CFP: 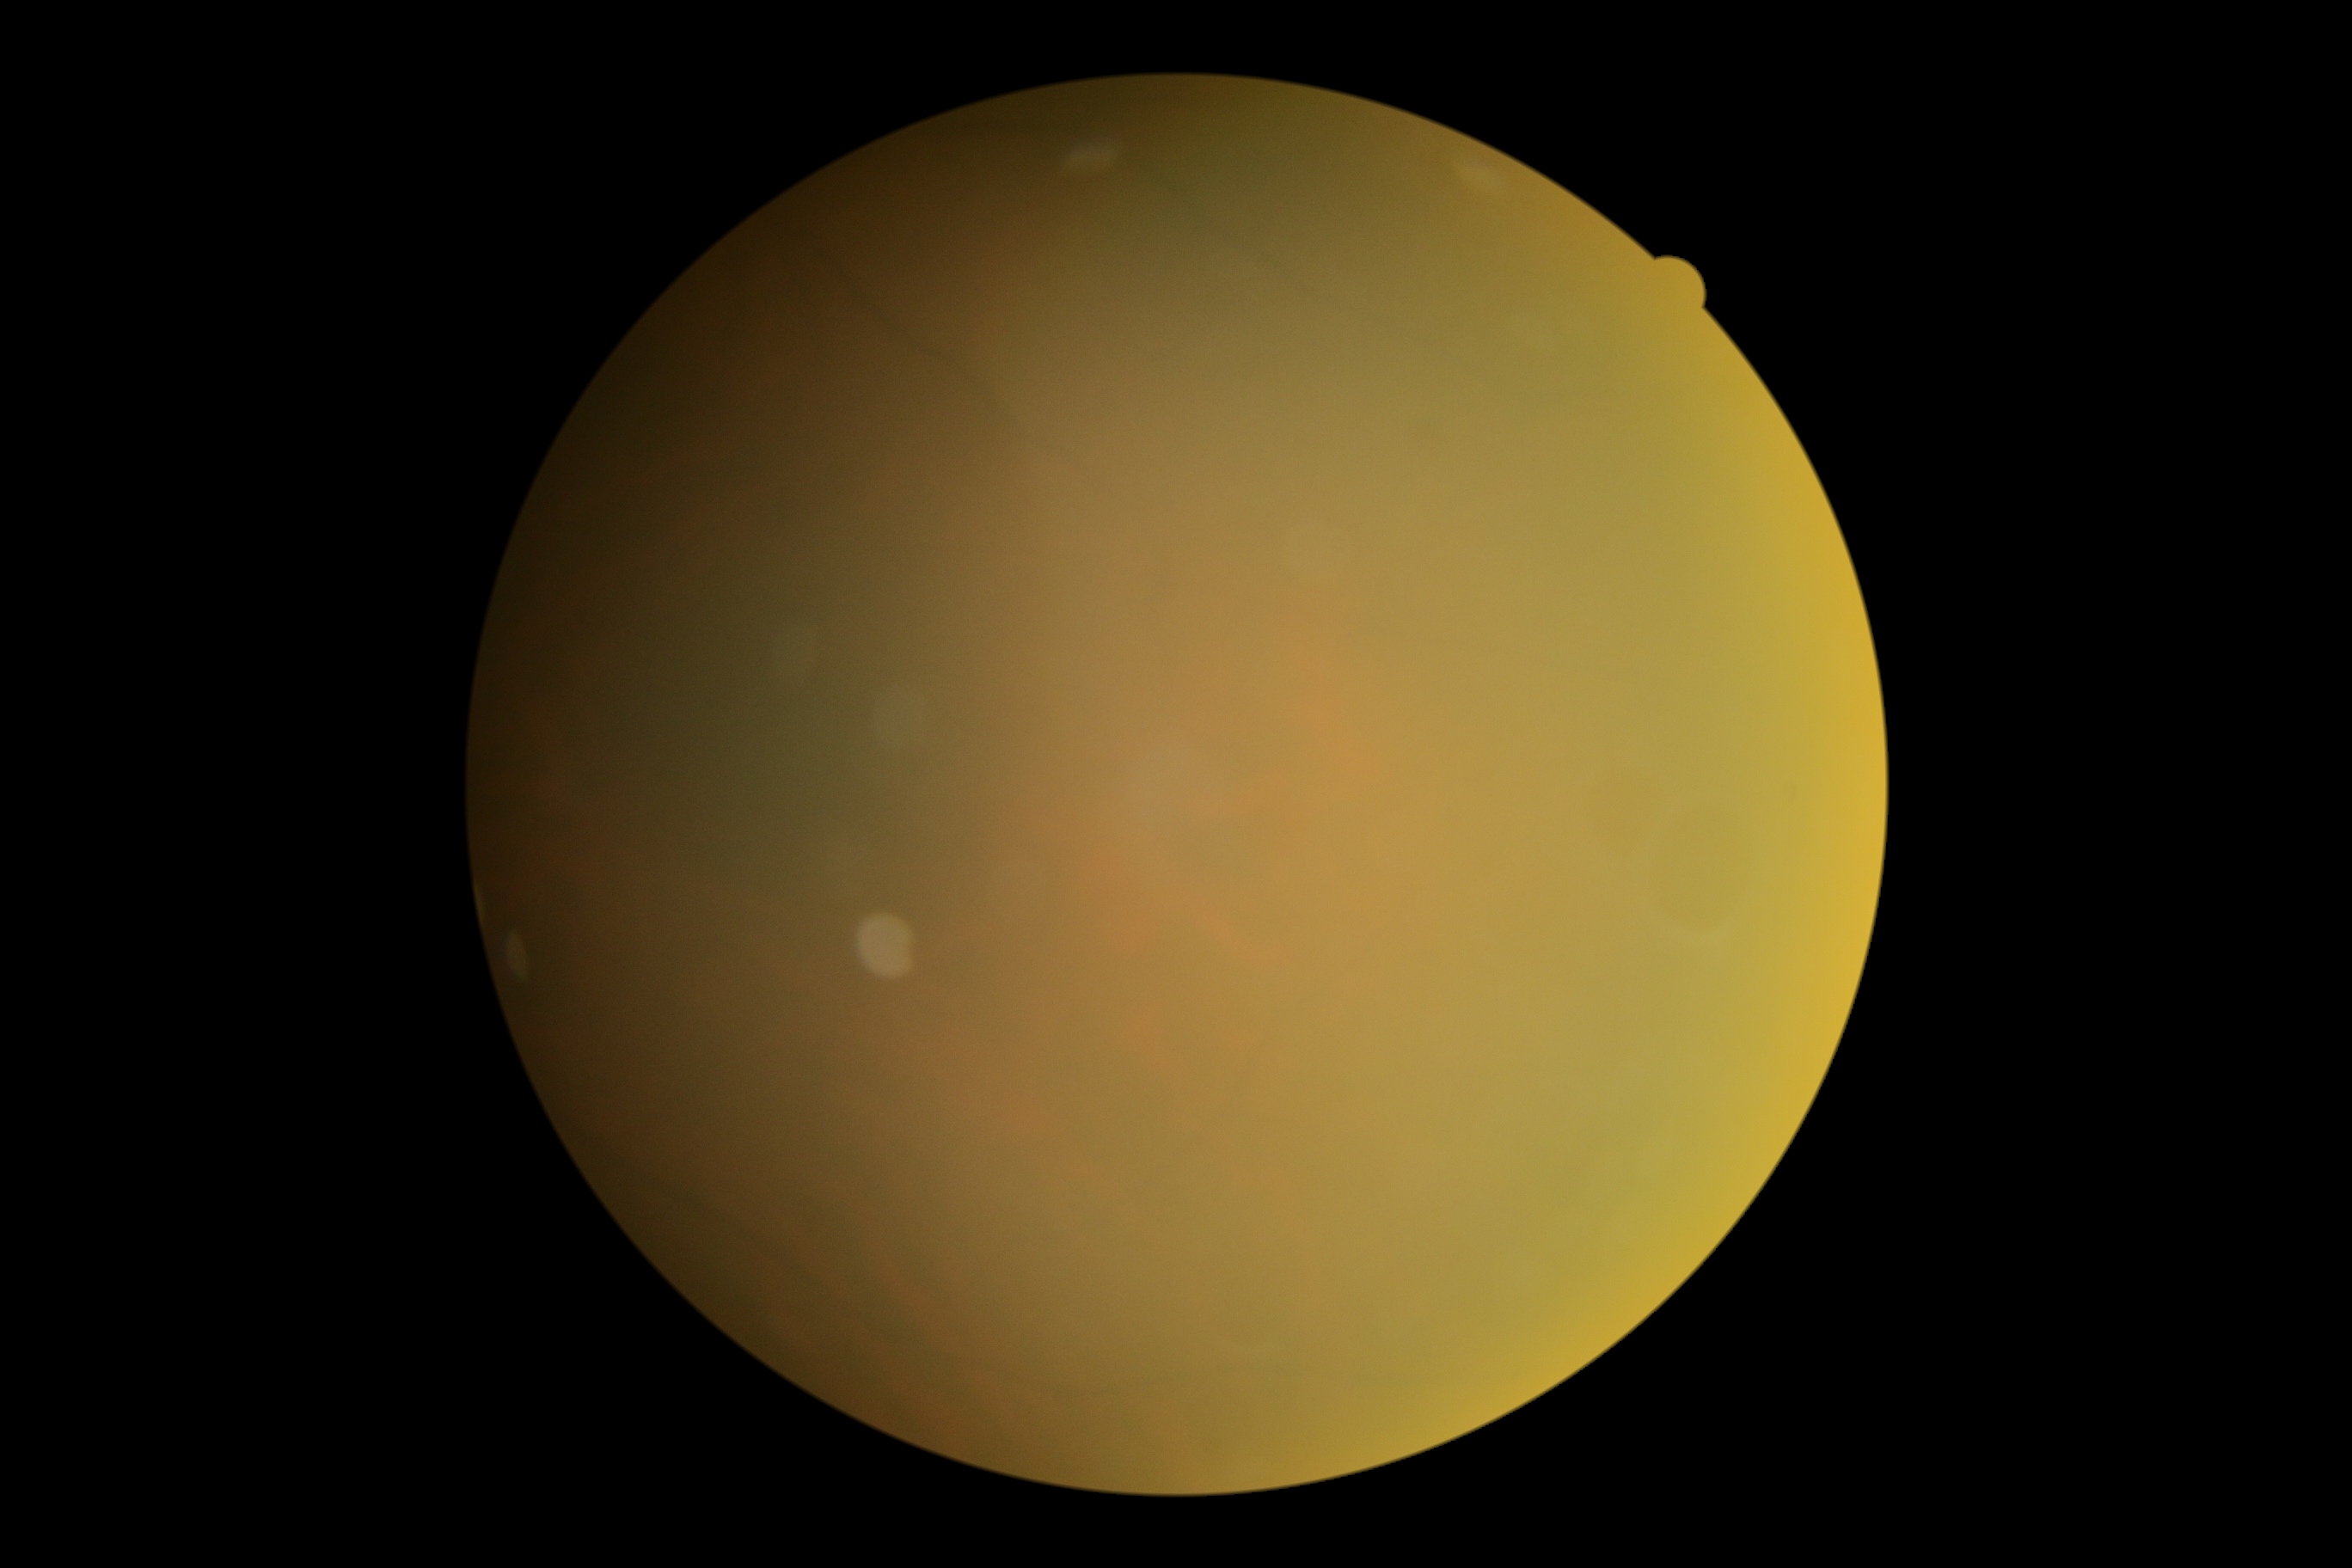 Retinopathy is ungradable due to poor image quality. Ungradable image — DR severity cannot be determined.